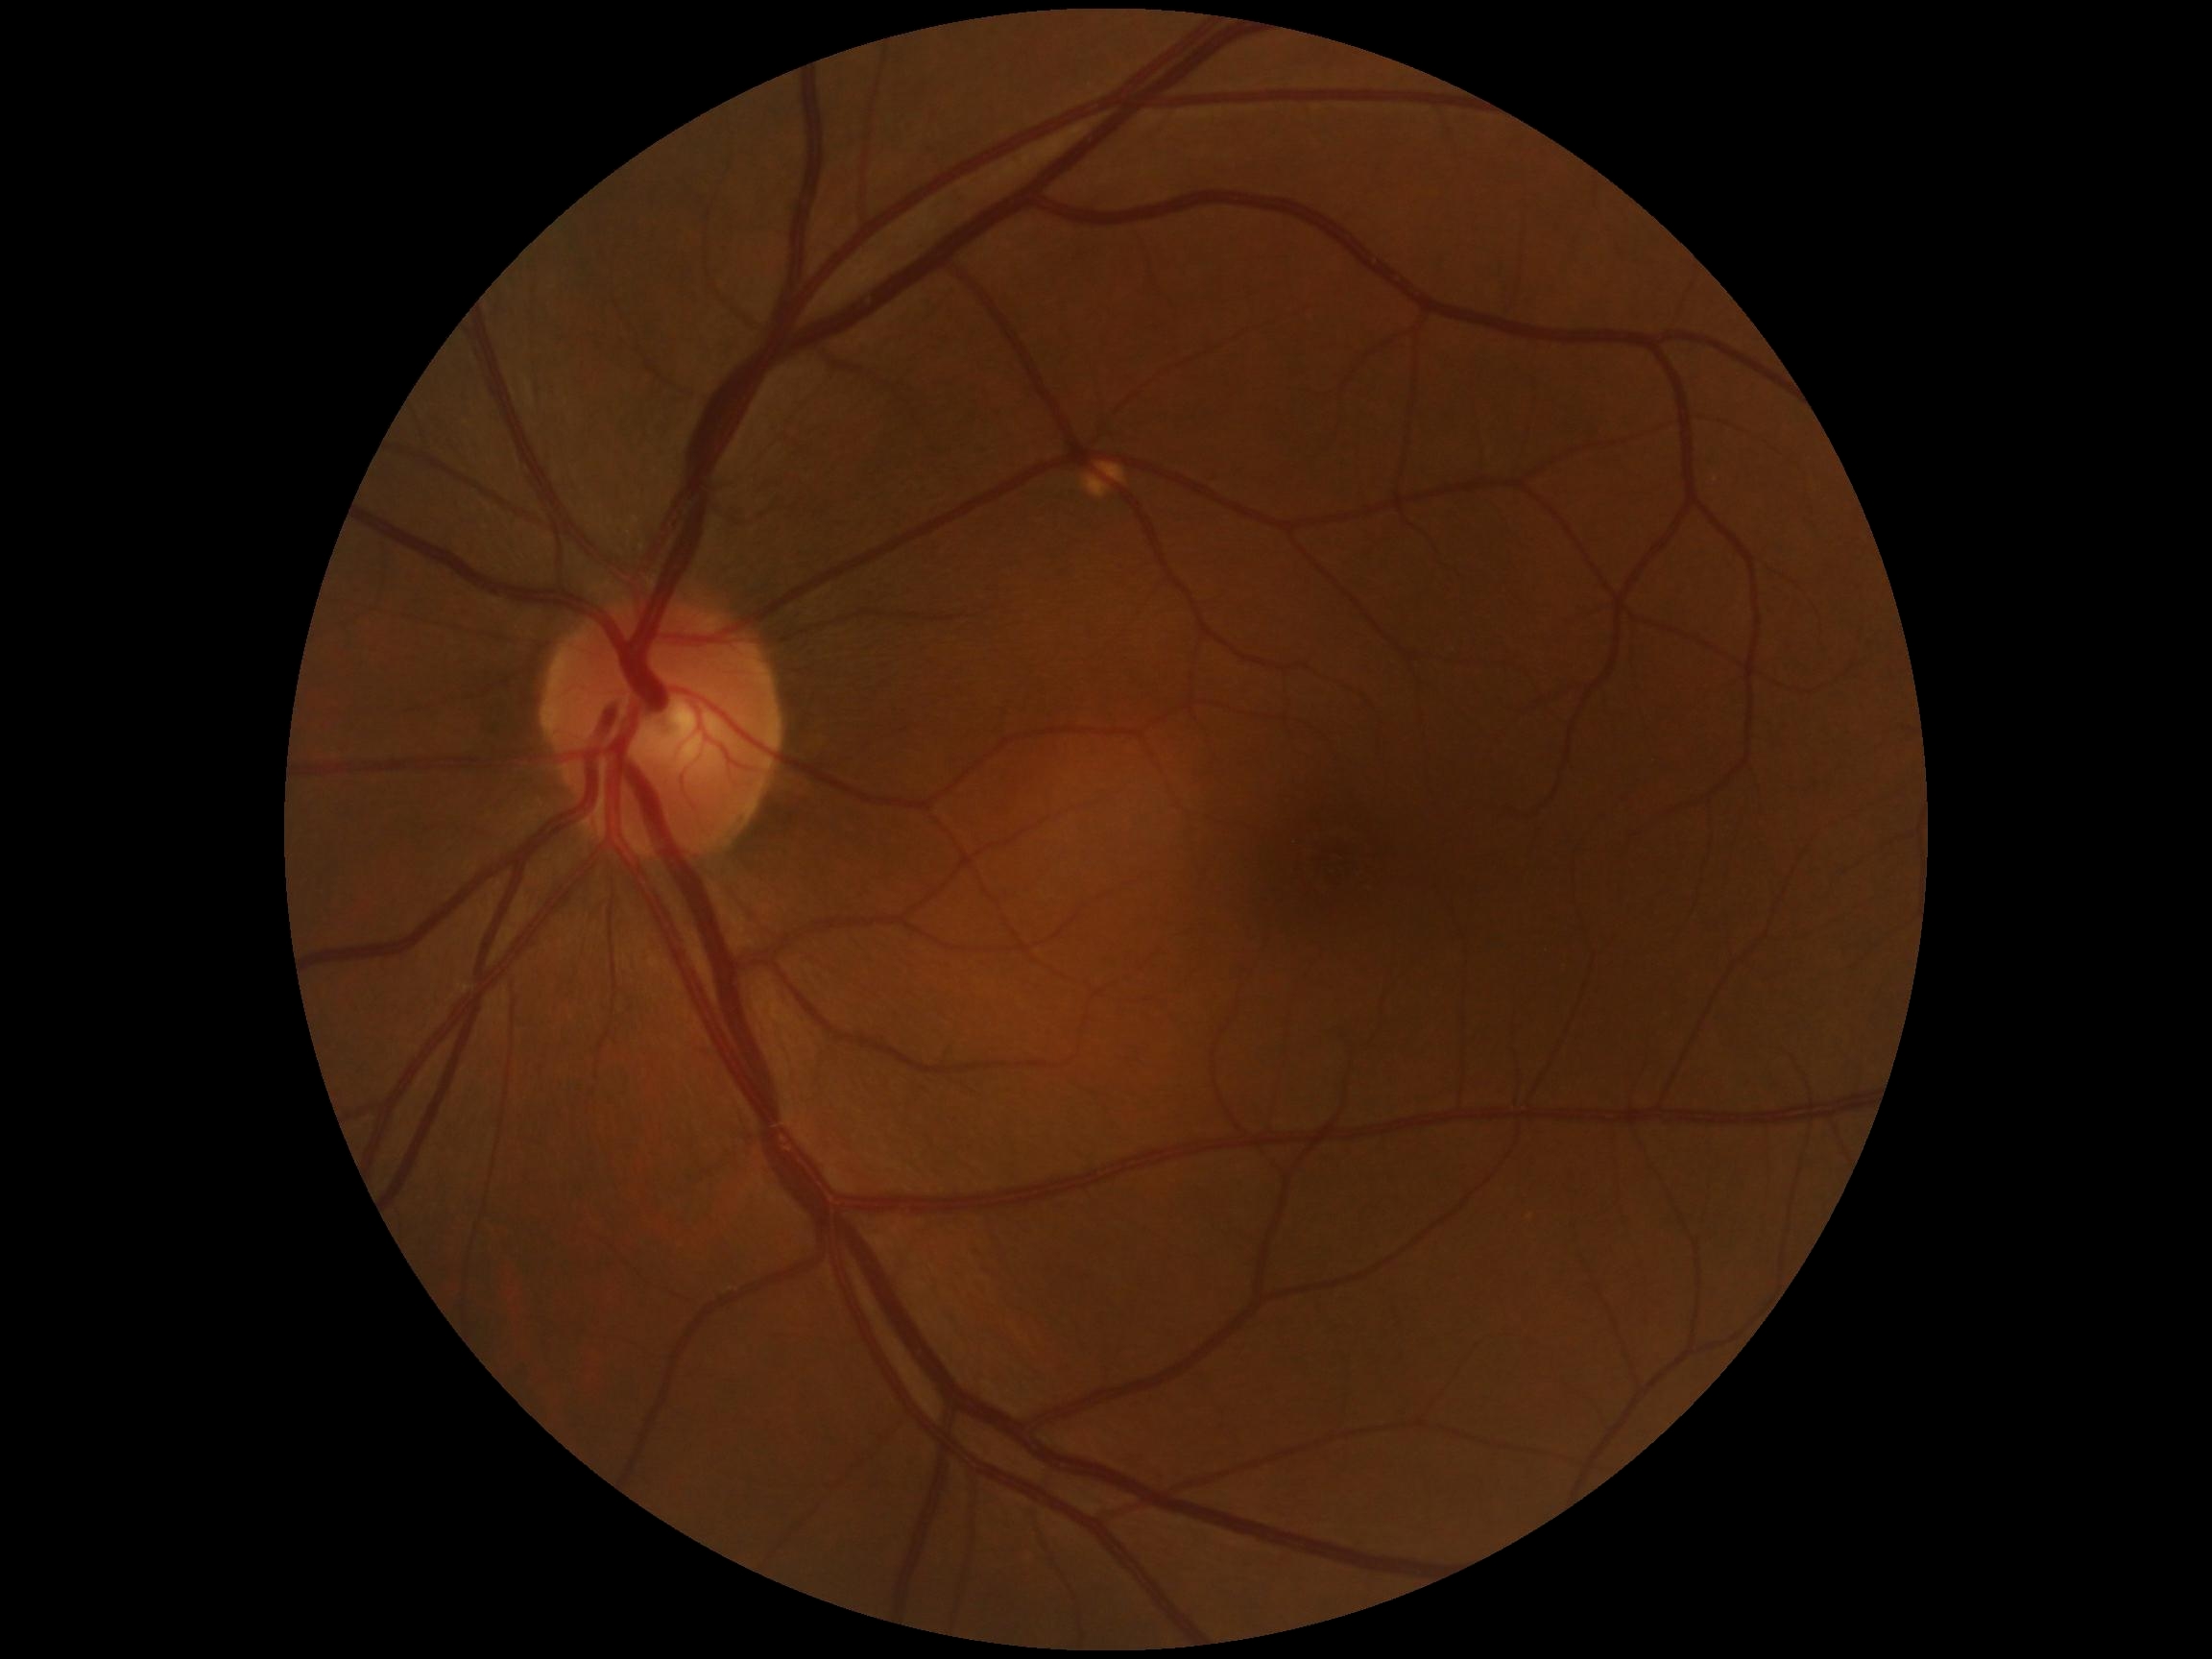 diabetic retinopathy (DR): grade 0 — no visible signs of diabetic retinopathy; DR impression: no apparent DR.